Image size 1440x1080 · wide-field fundus image from infant ROP screening:
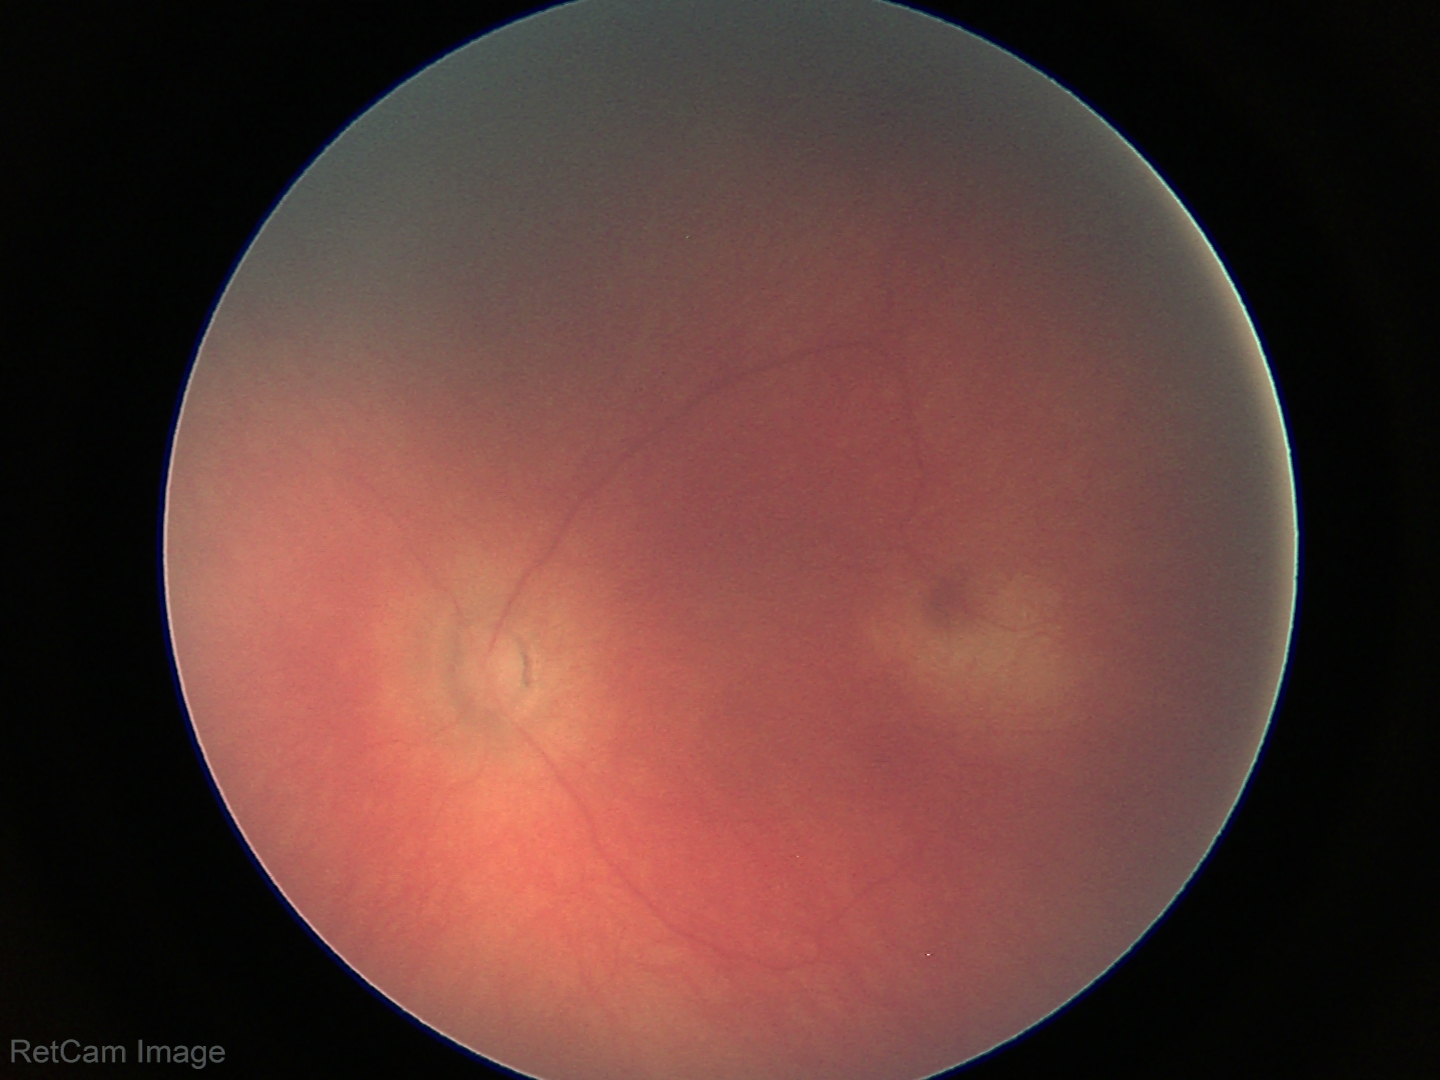
Examination with physiological retinal findings.